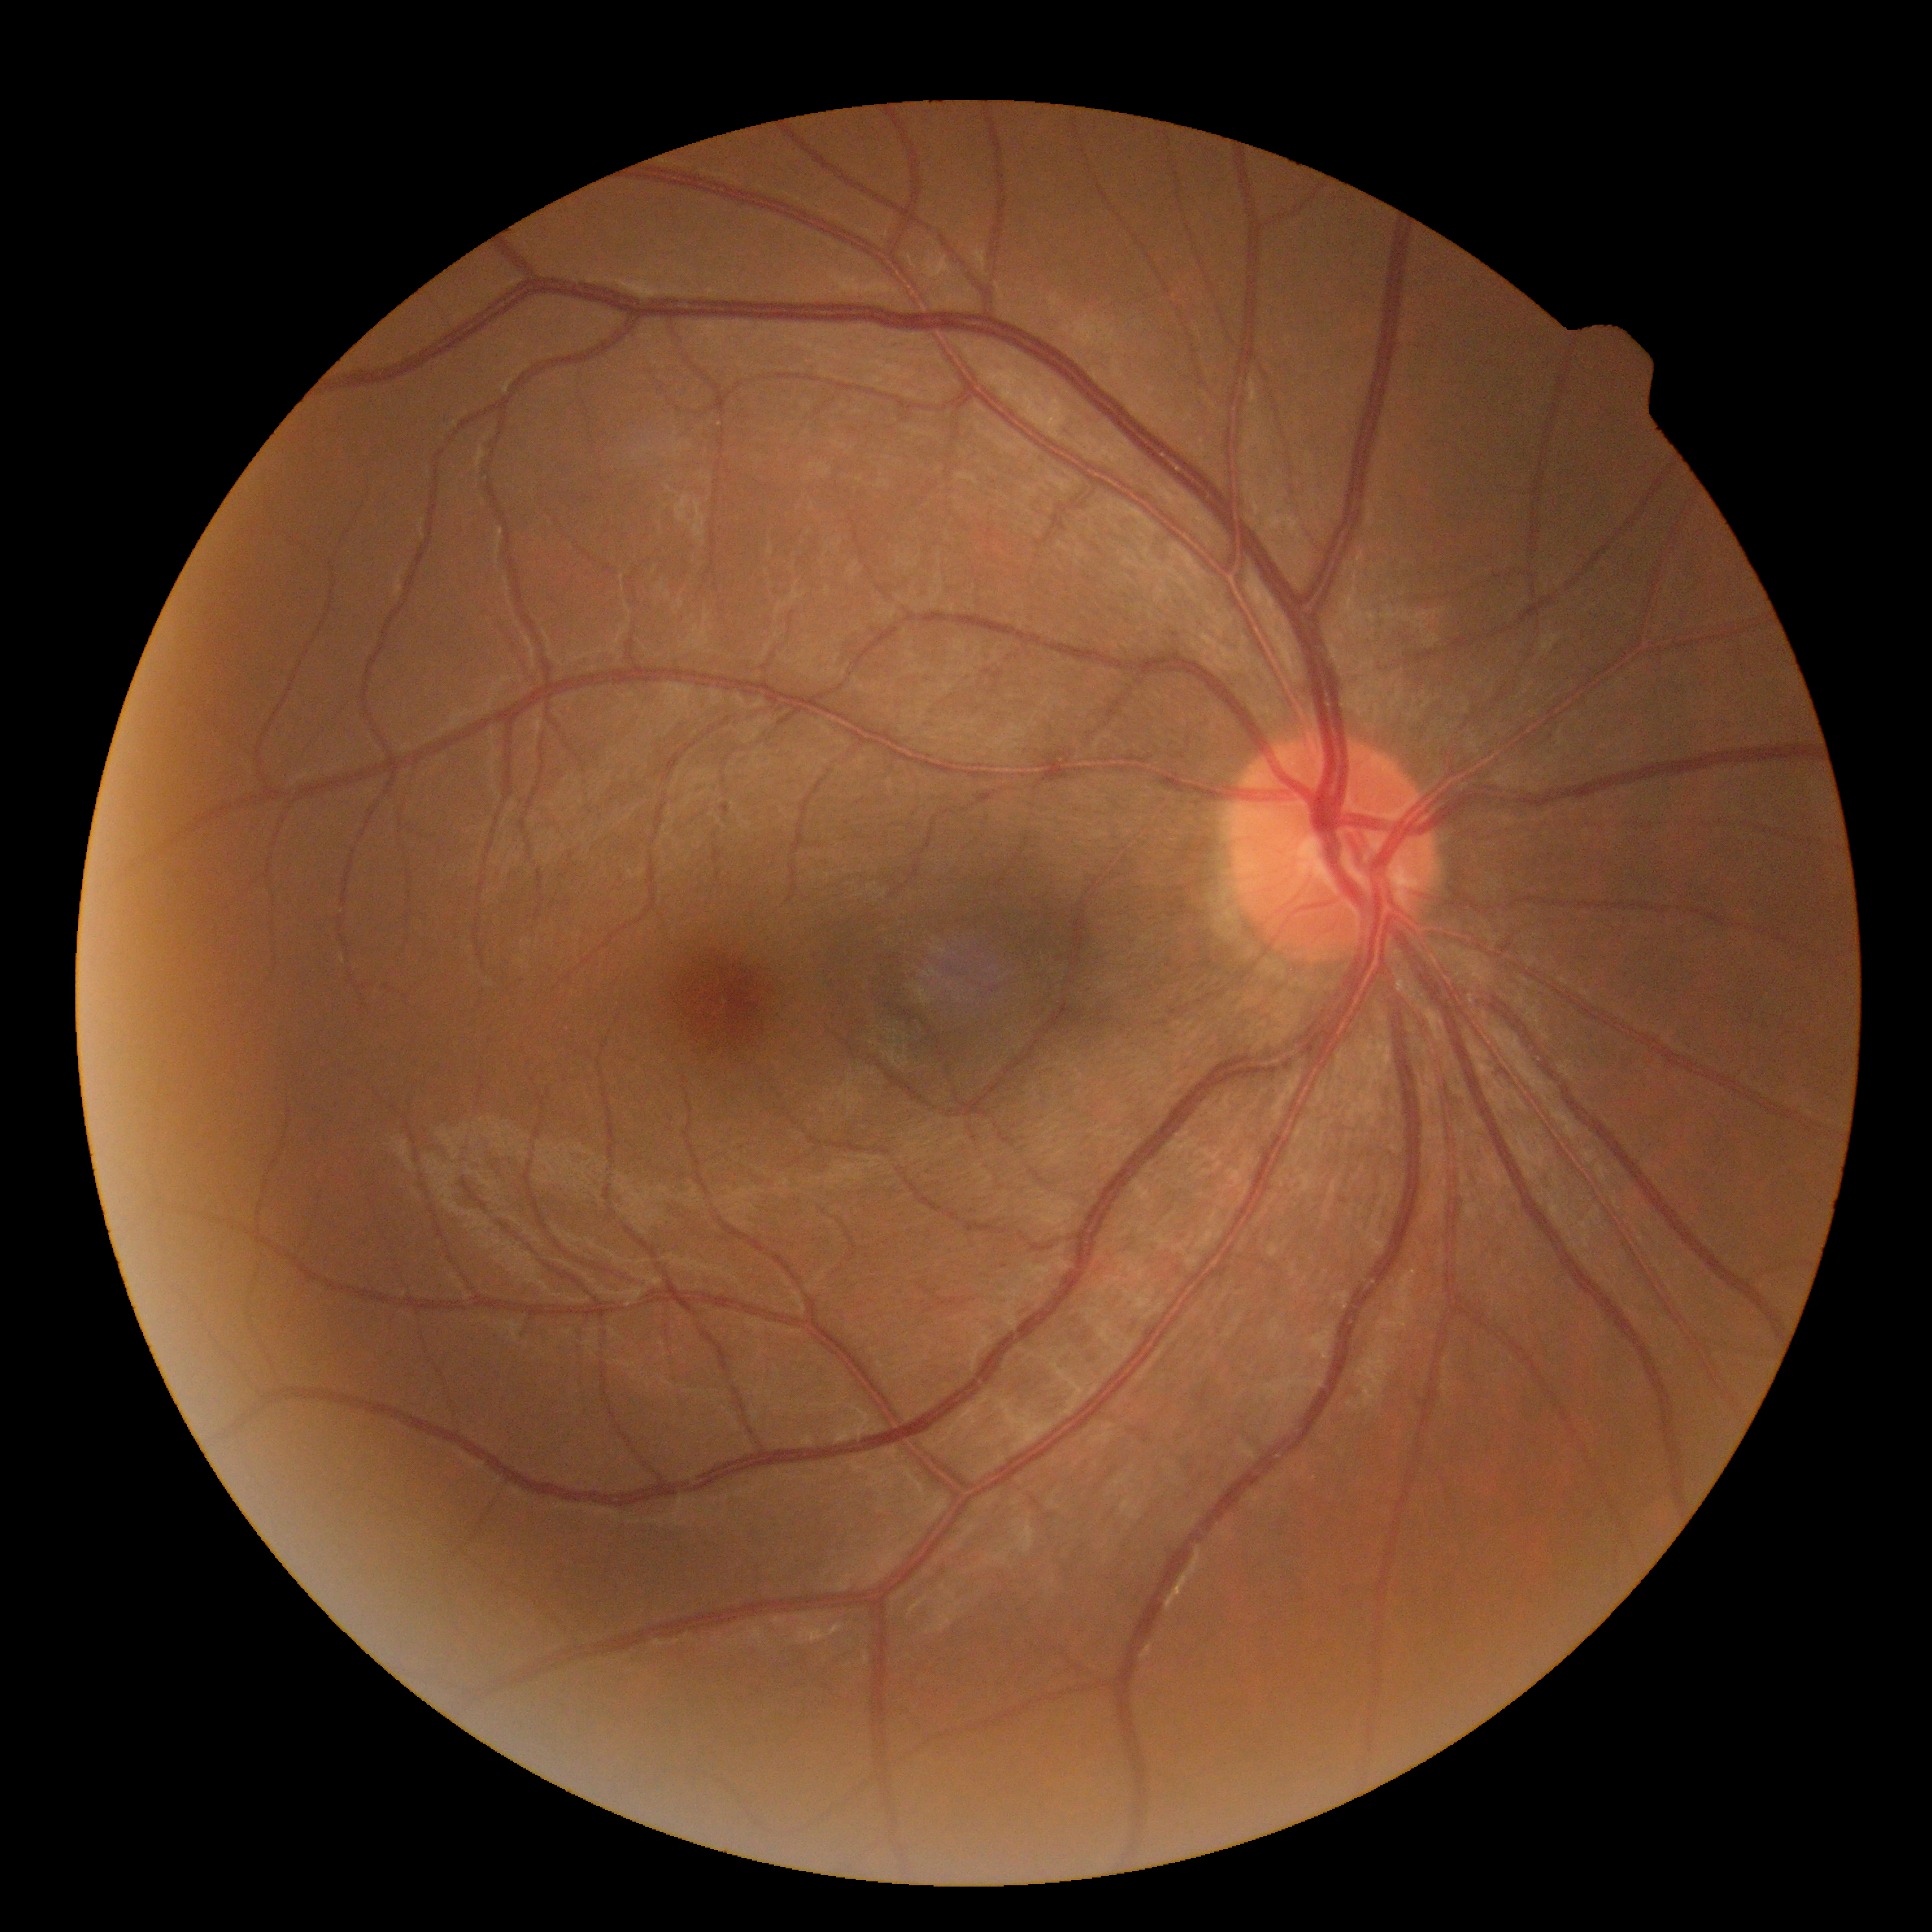 Diabetic retinopathy is 0 — no visible signs of diabetic retinopathy.